Image size 2352x1568.
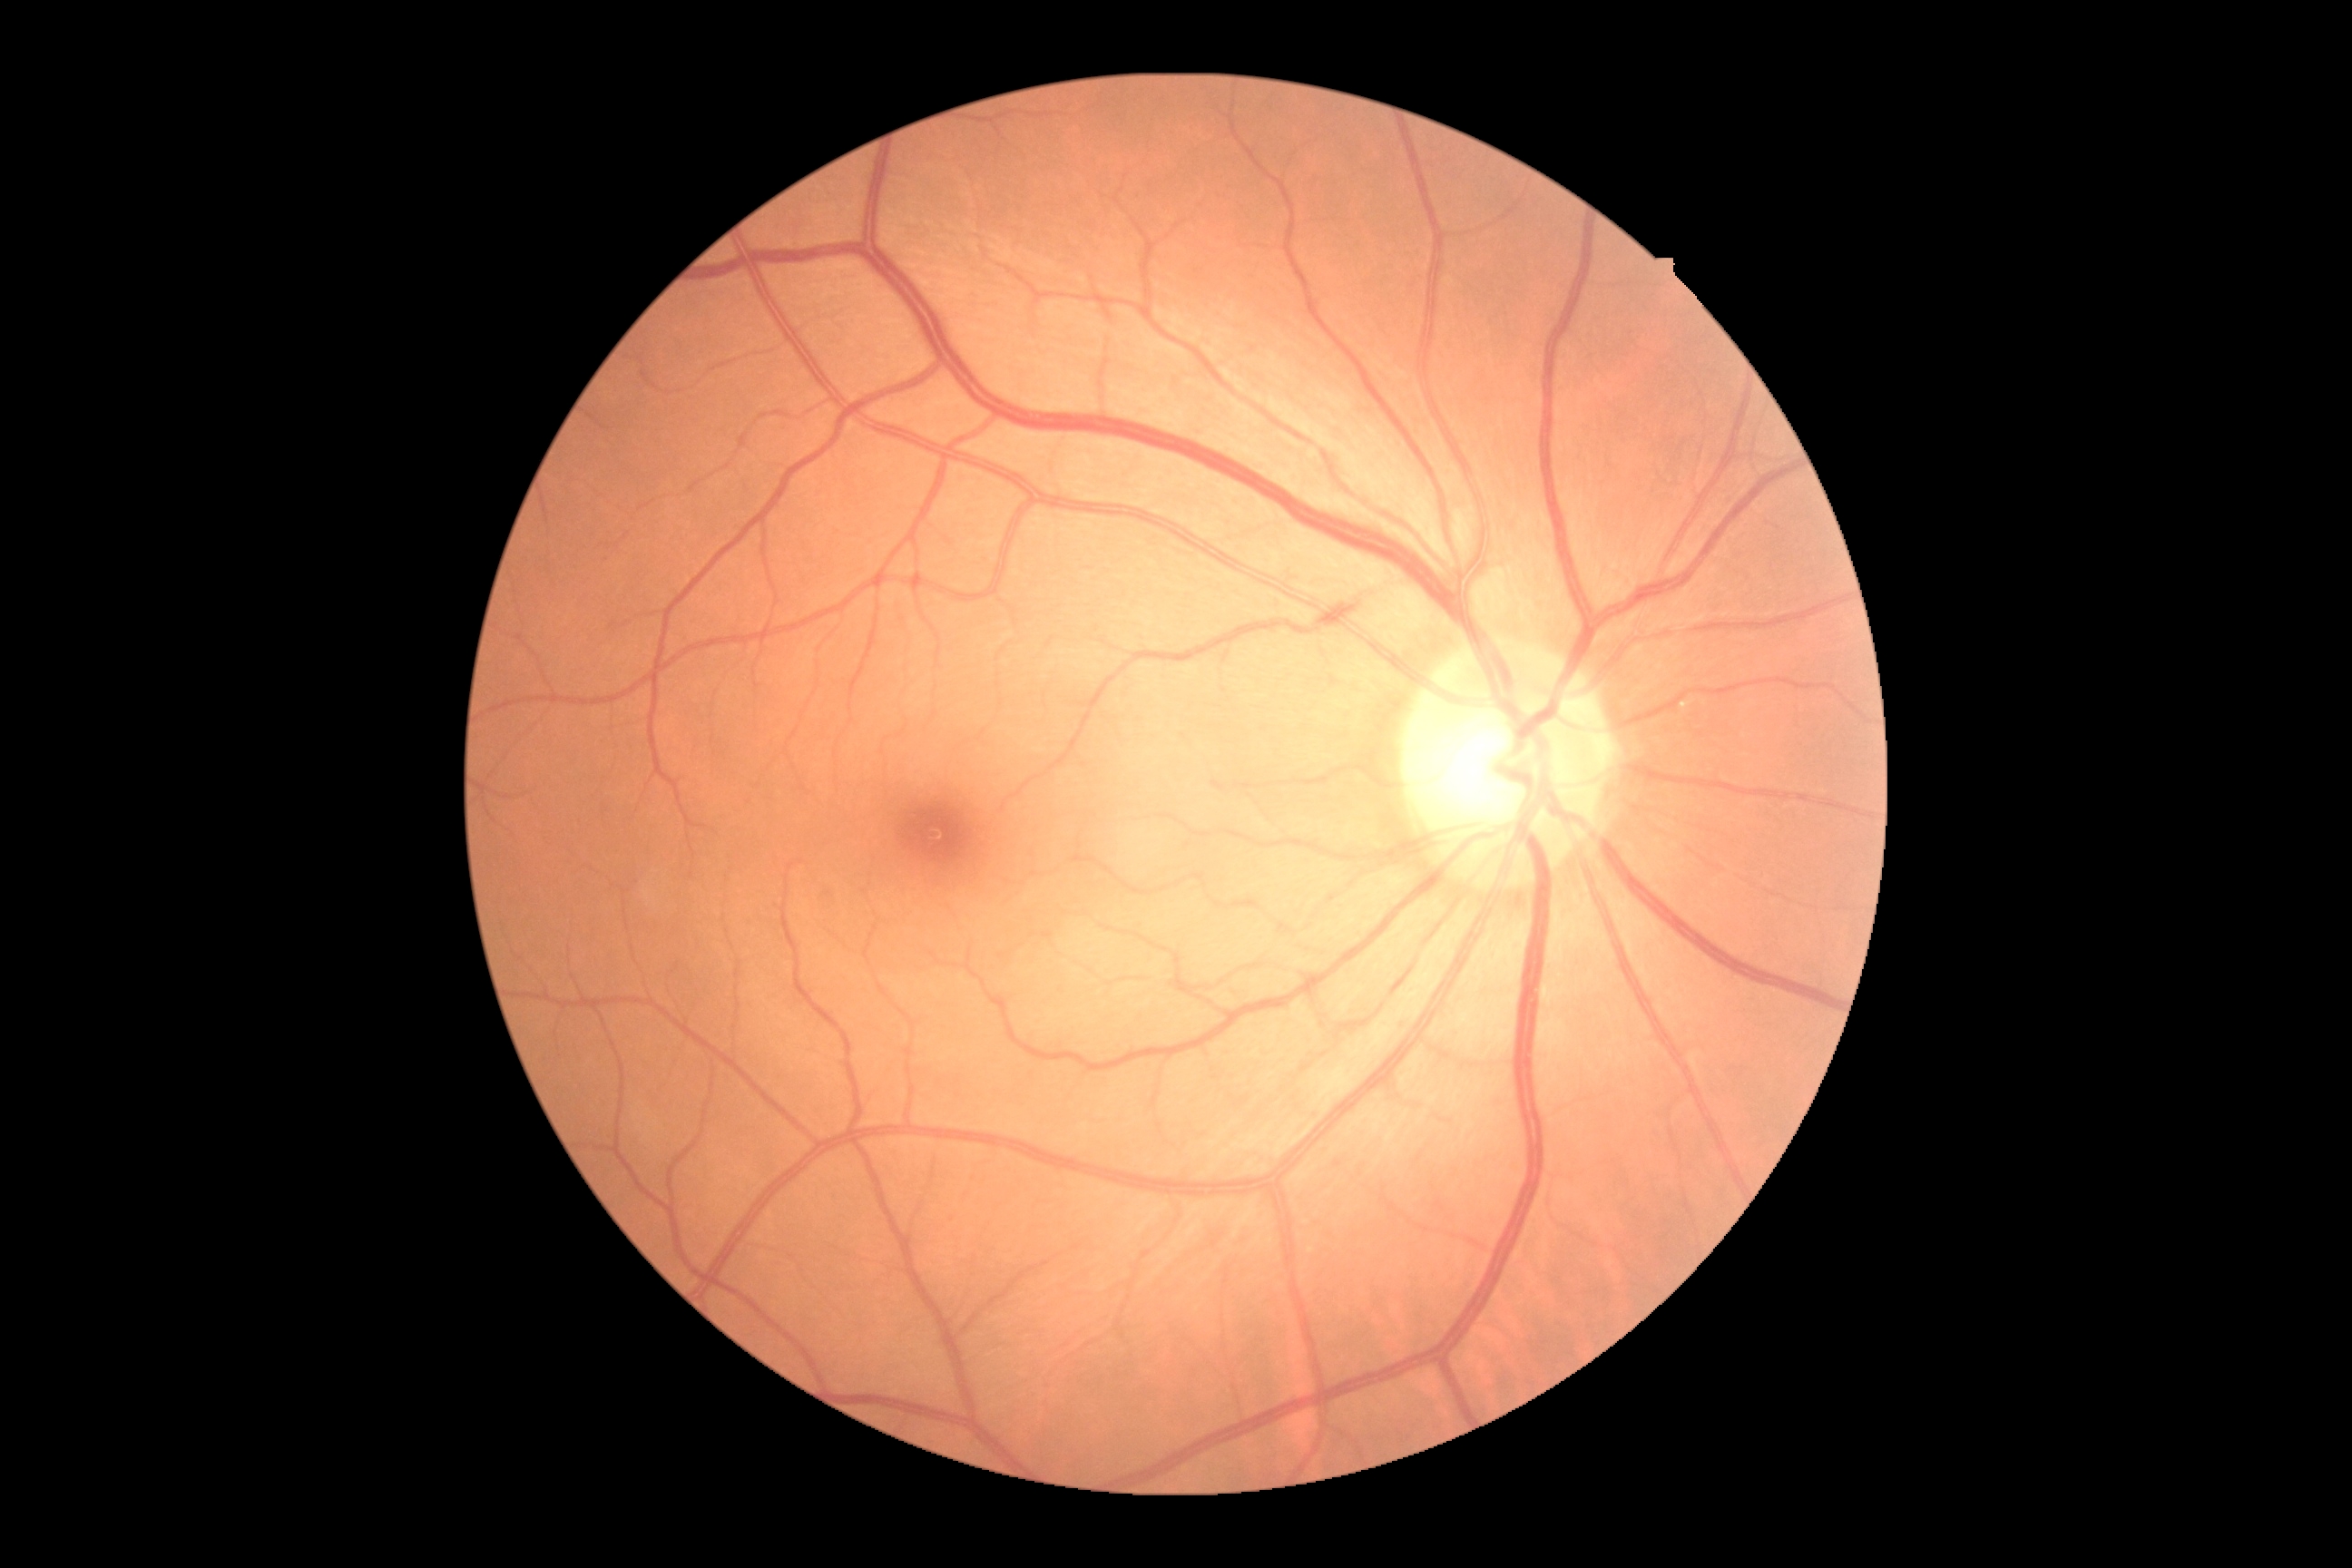
DR is grade 0 (no apparent retinopathy). No apparent diabetic retinopathy.